Captured with the Clarity RetCam 3 (130° field of view) · wide-field fundus image from infant ROP screening: 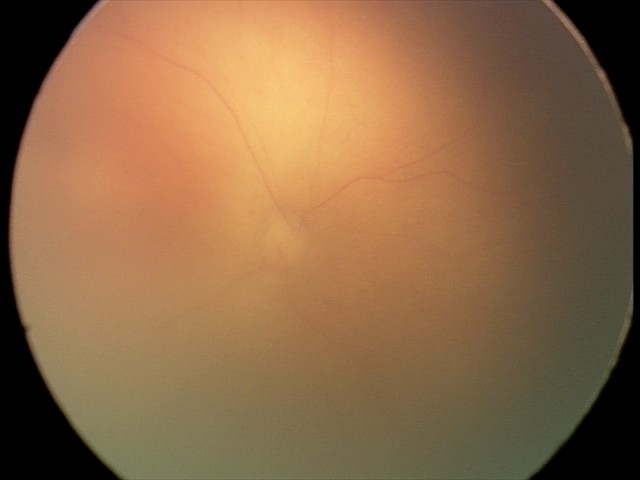
Assessment: ROP stage 0.